RetCam wide-field infant fundus image · 1440x1080
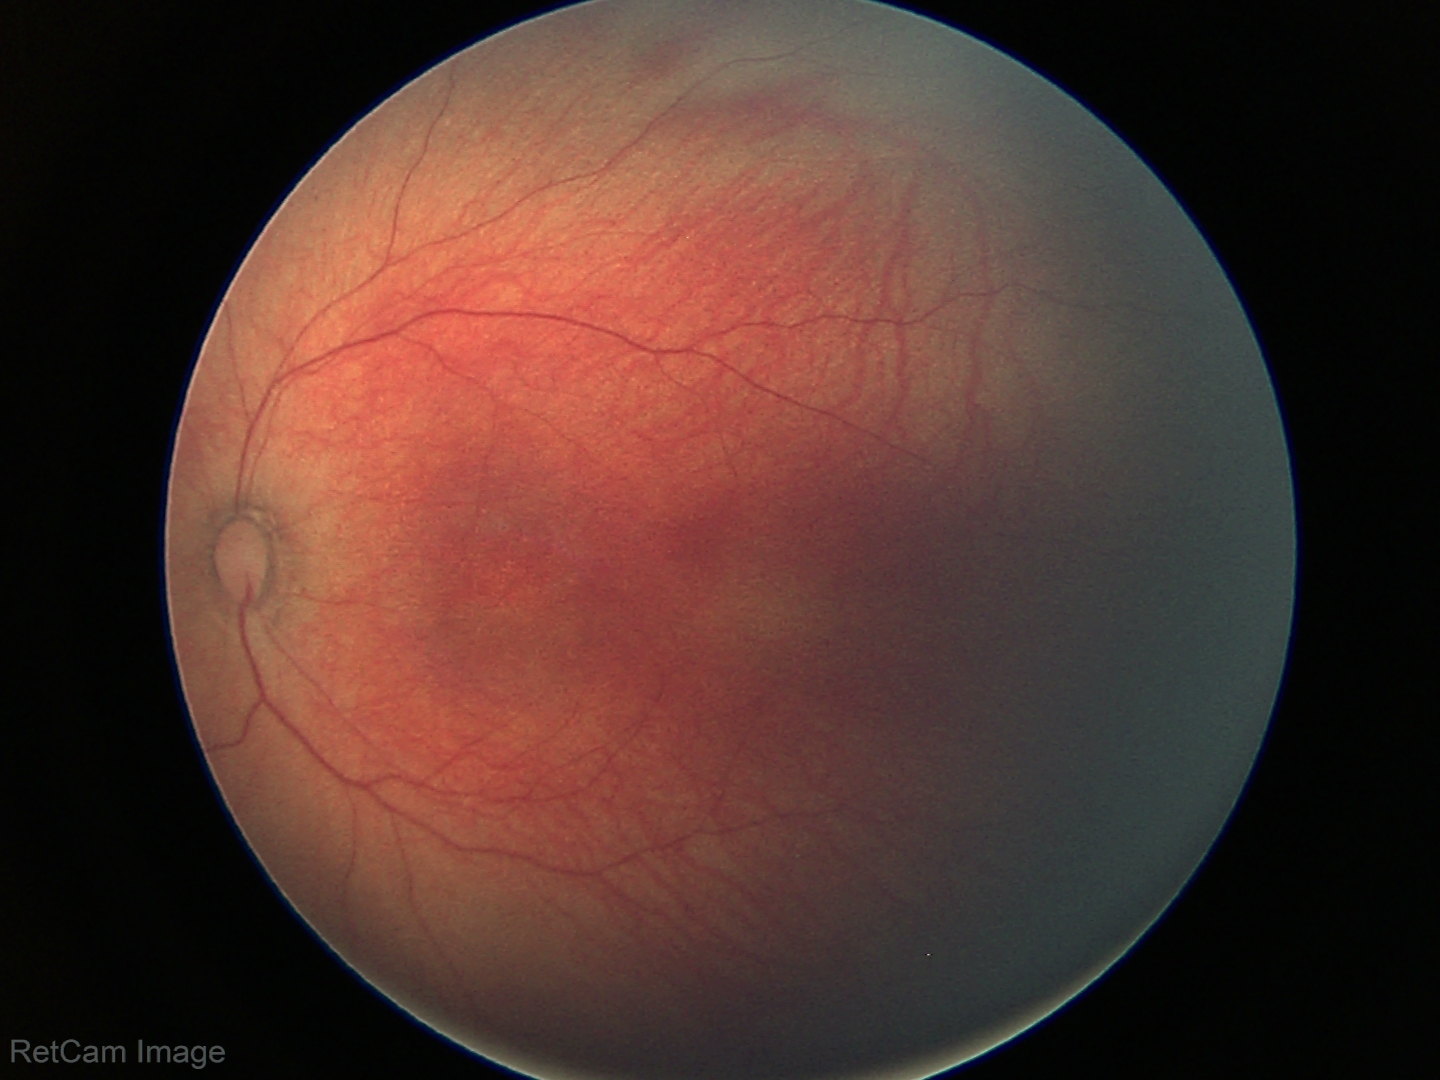 Q: What was the screening finding?
A: physiological finding